Wide-field fundus photograph of an infant: 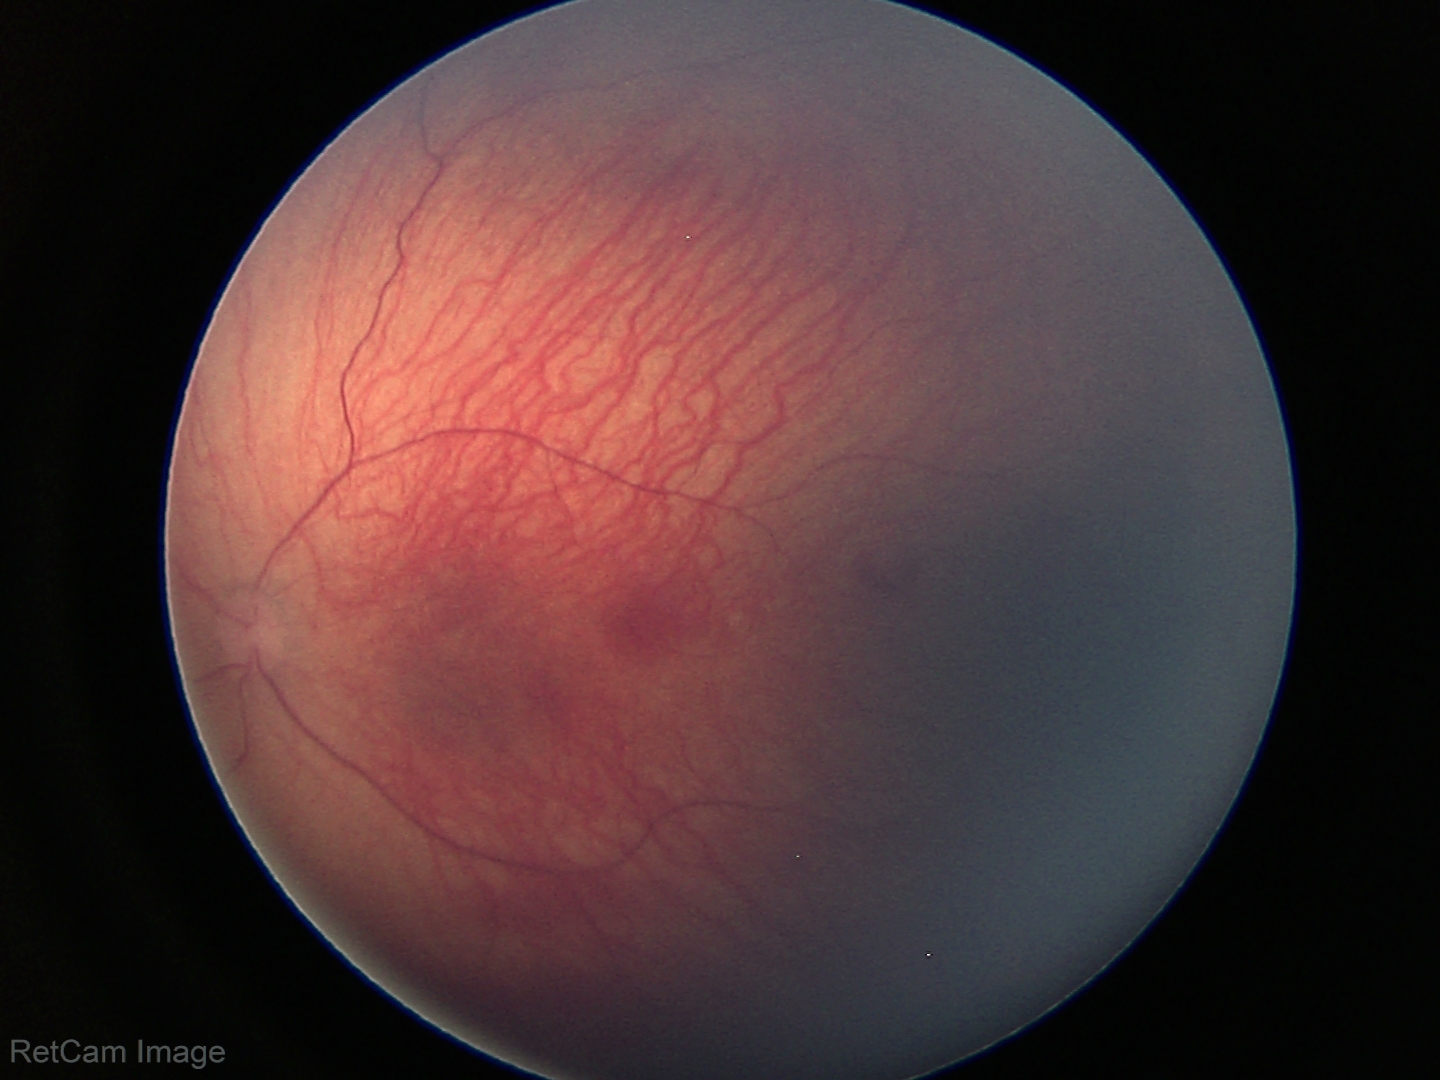

Series diagnosed as retinopathy of prematurity stage 1.